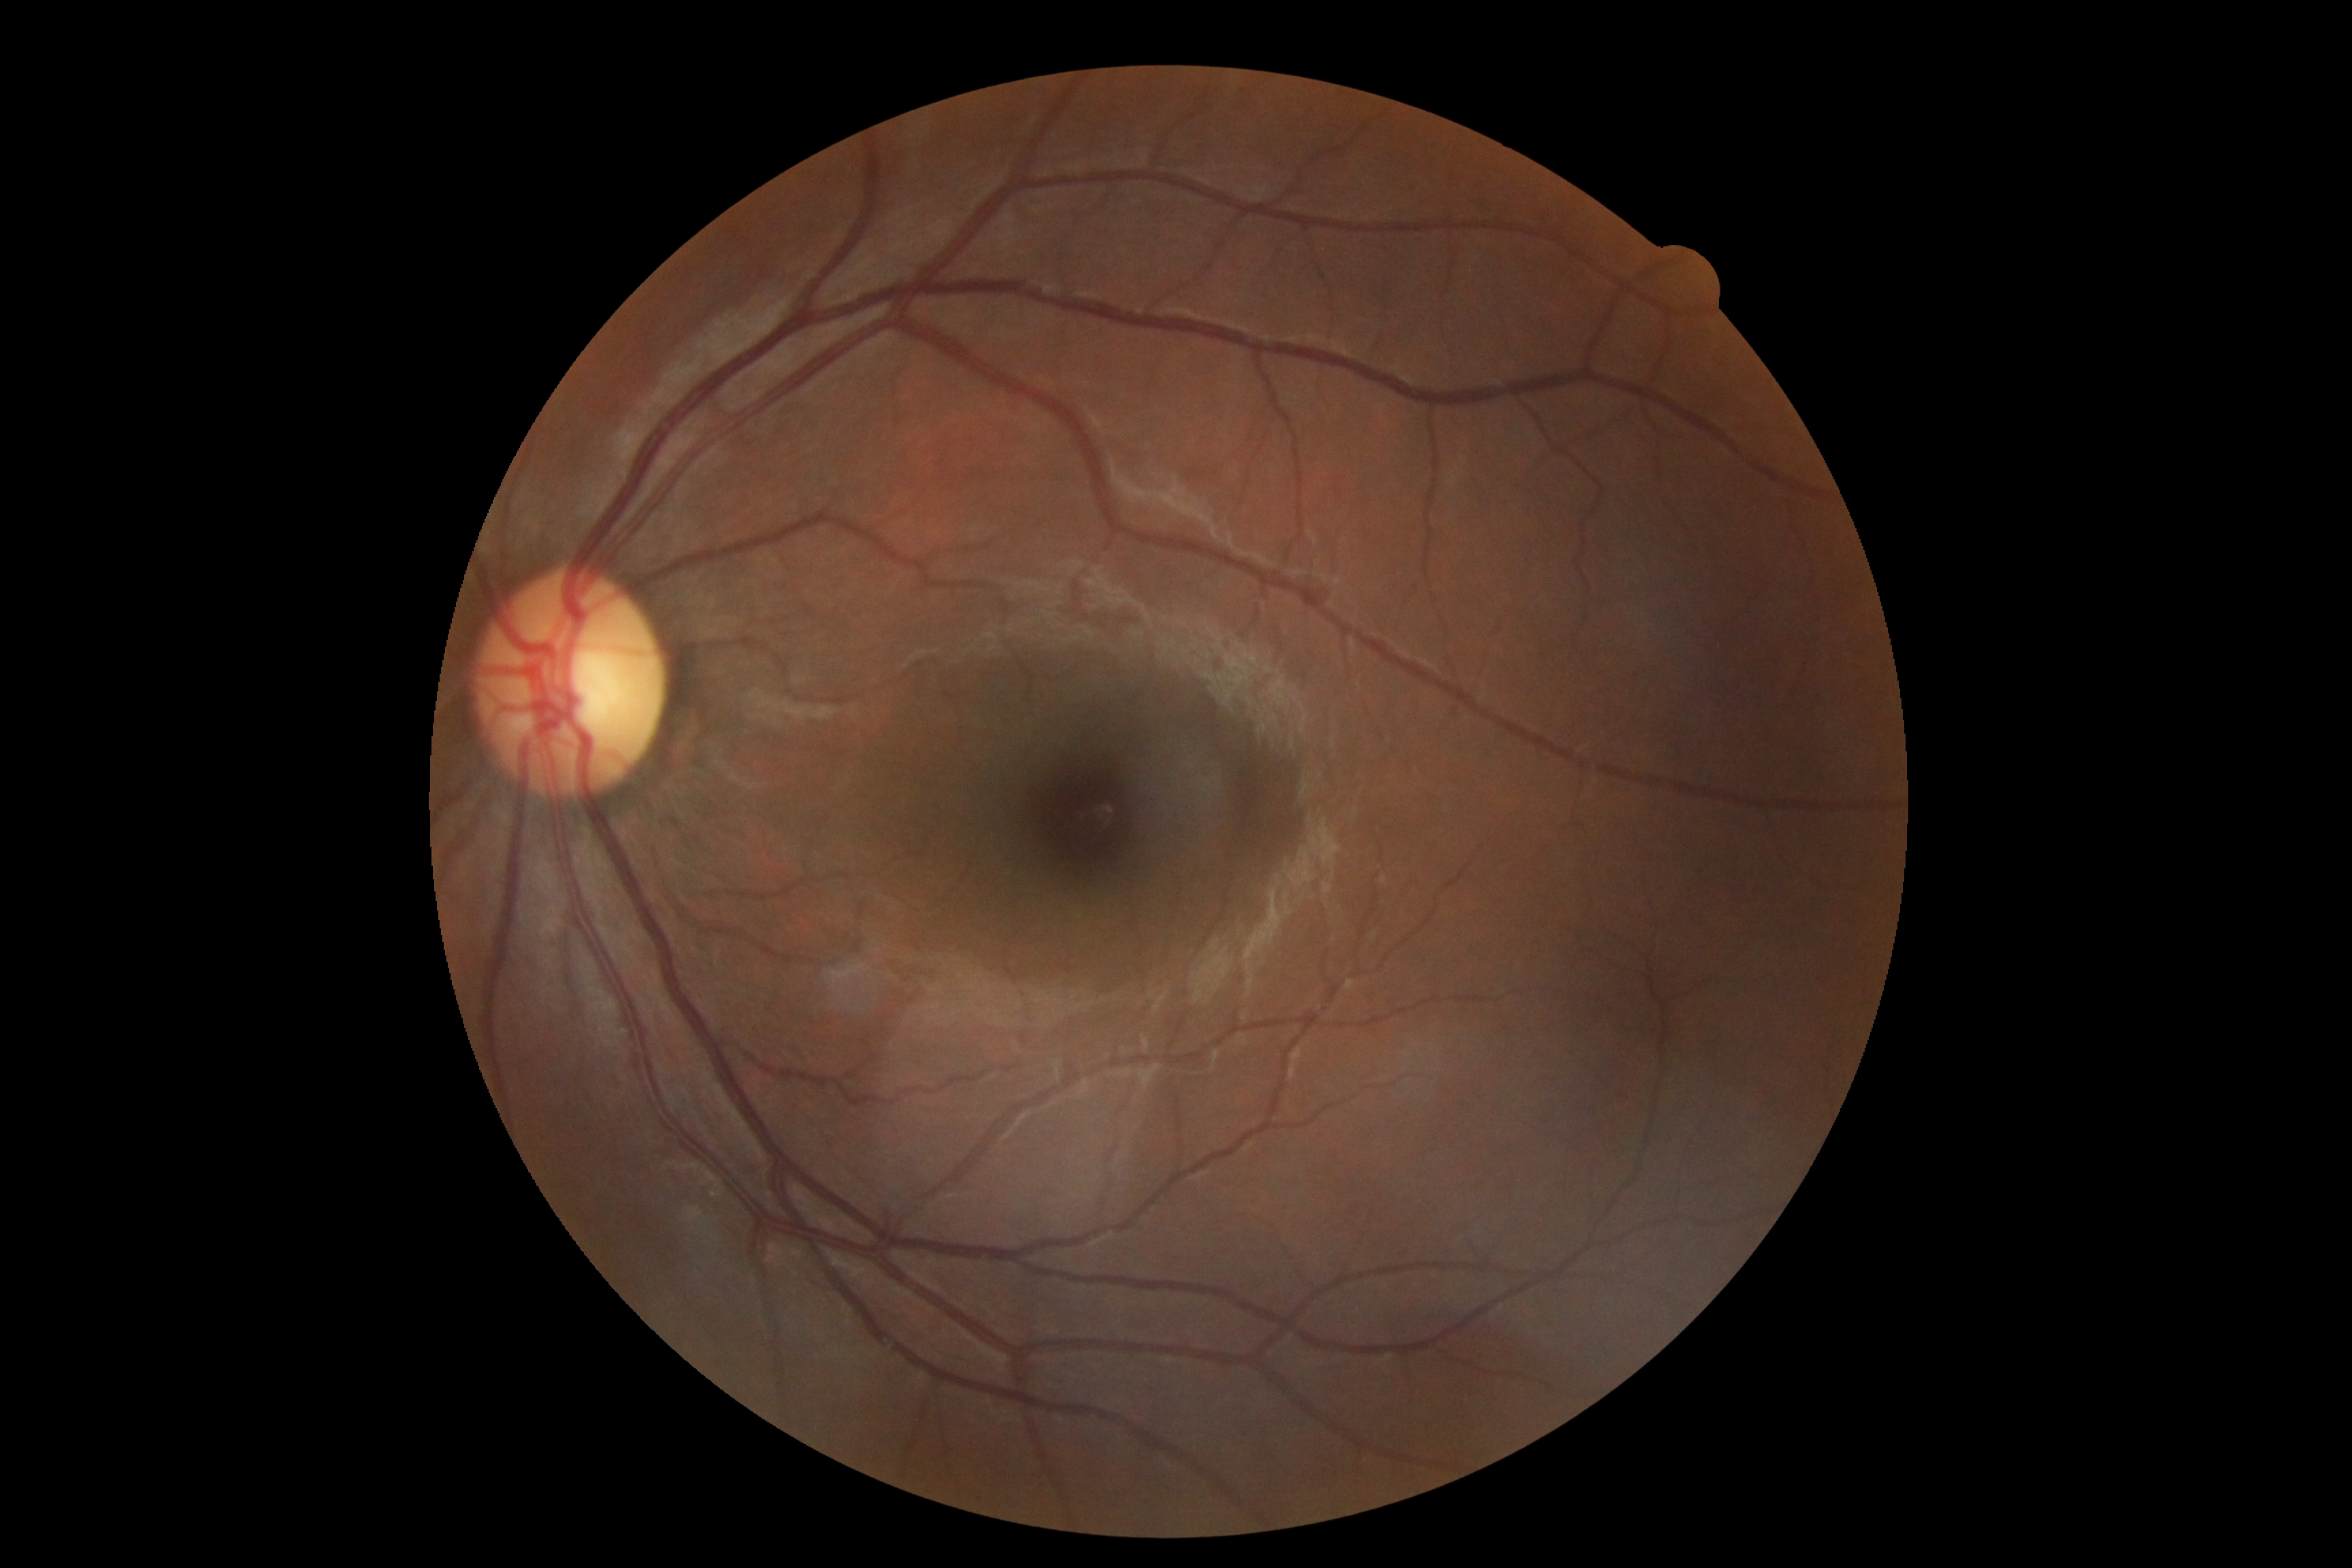

Diabetic retinopathy (DR) is 0/4 — no visible signs of diabetic retinopathy.